45-degree field of view.
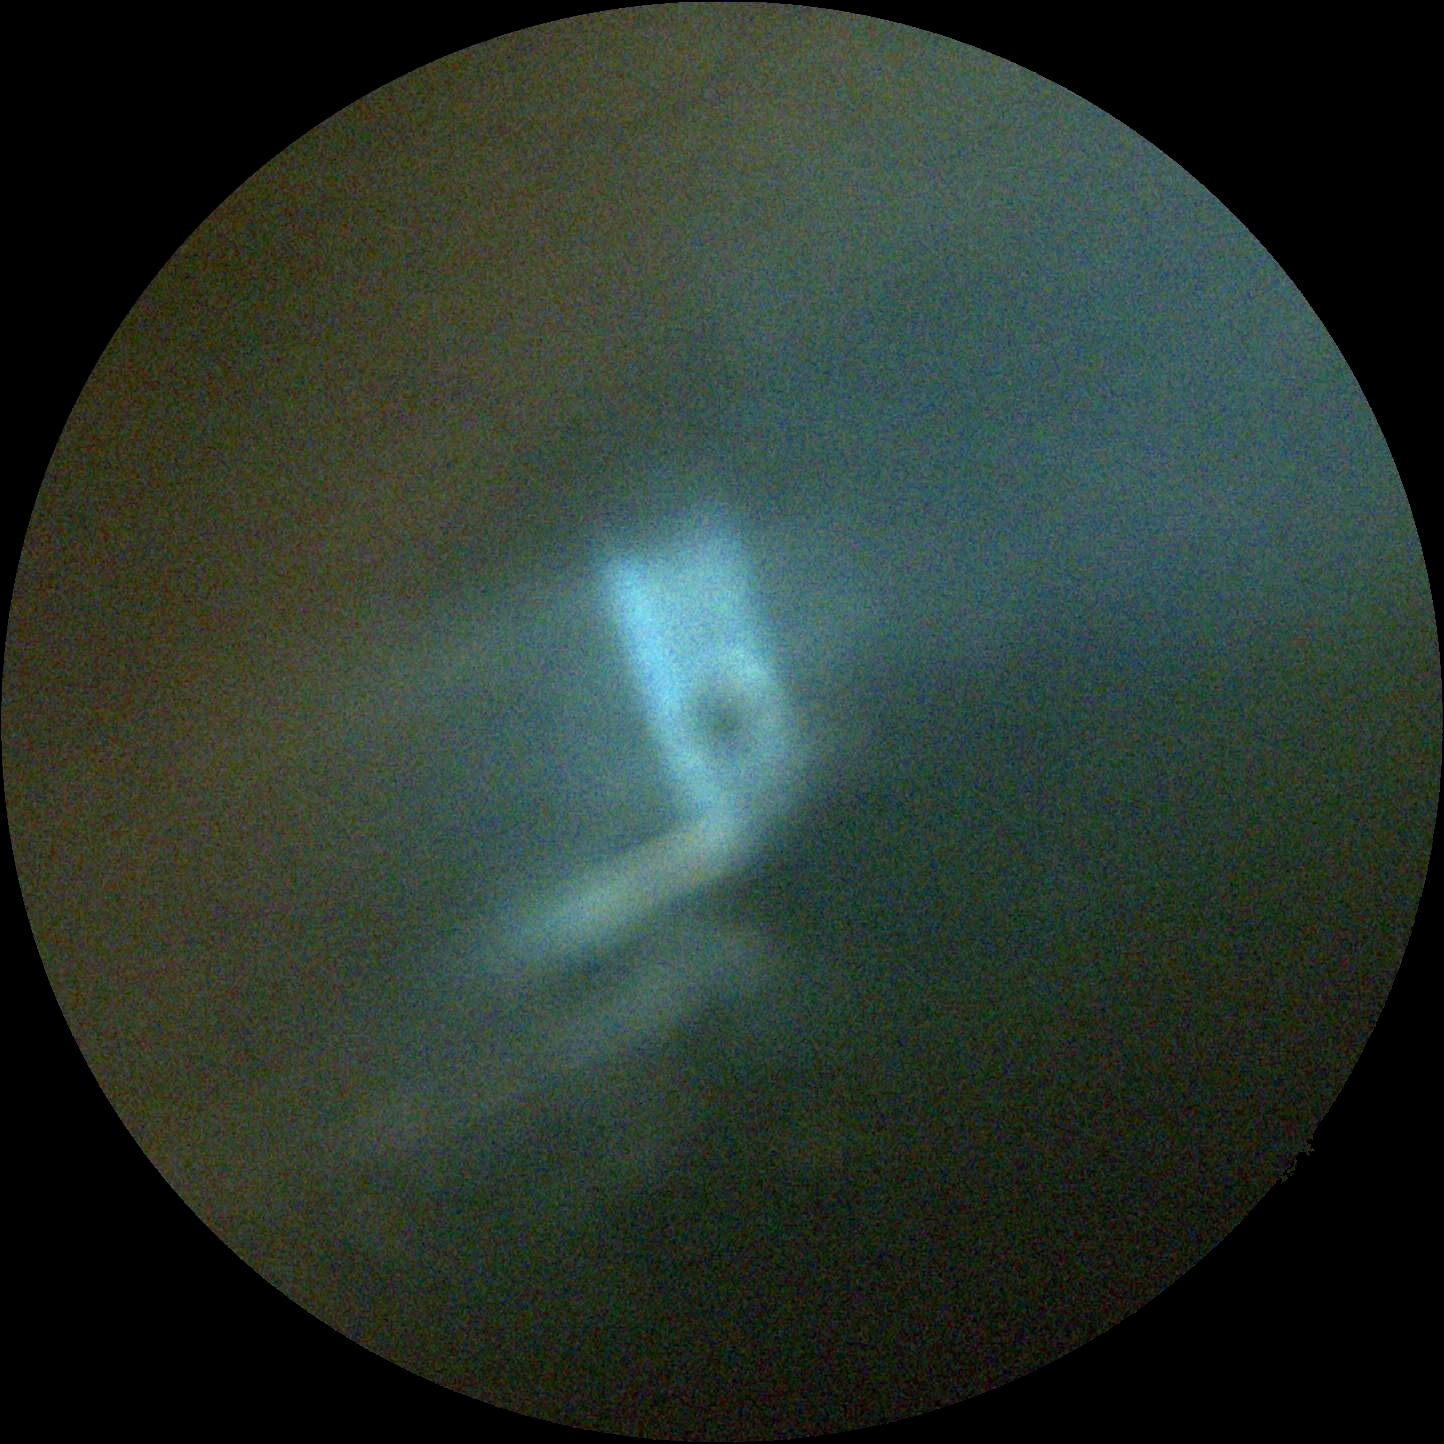 DR severity@ungradable, image quality@below grading threshold.